Acquired with a NIDEK AFC-230 · nonmydriatic · 848 x 848 pixels · 45-degree field of view
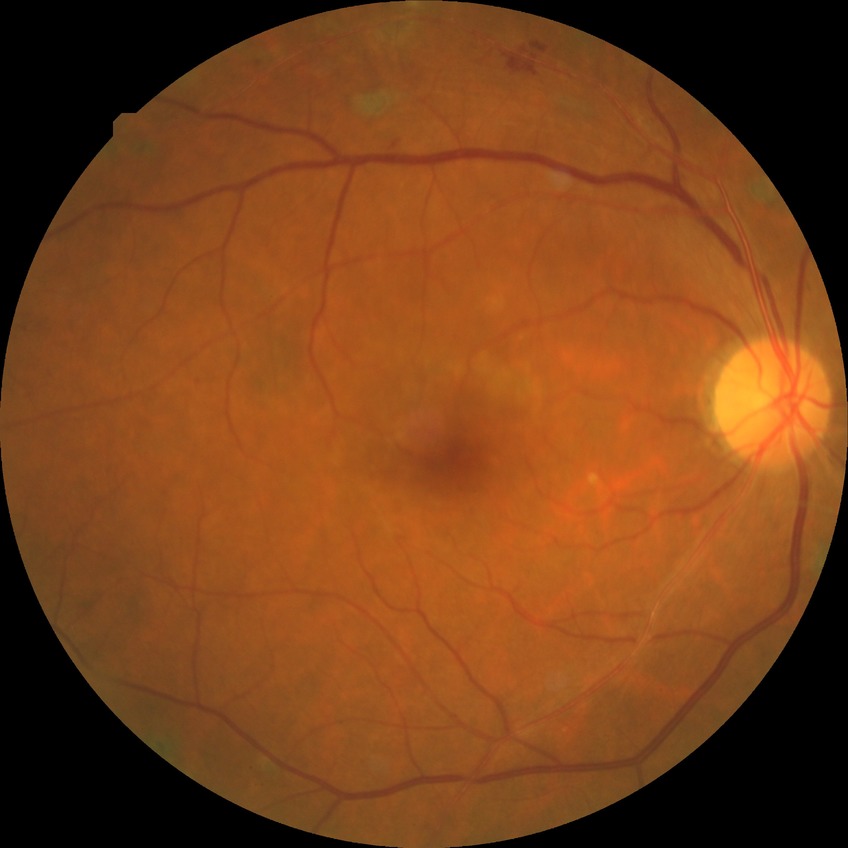
Diabetic retinopathy severity: proliferative diabetic retinopathy.